848 x 848 pixels; nonmydriatic; camera: NIDEK AFC-230; color fundus image.
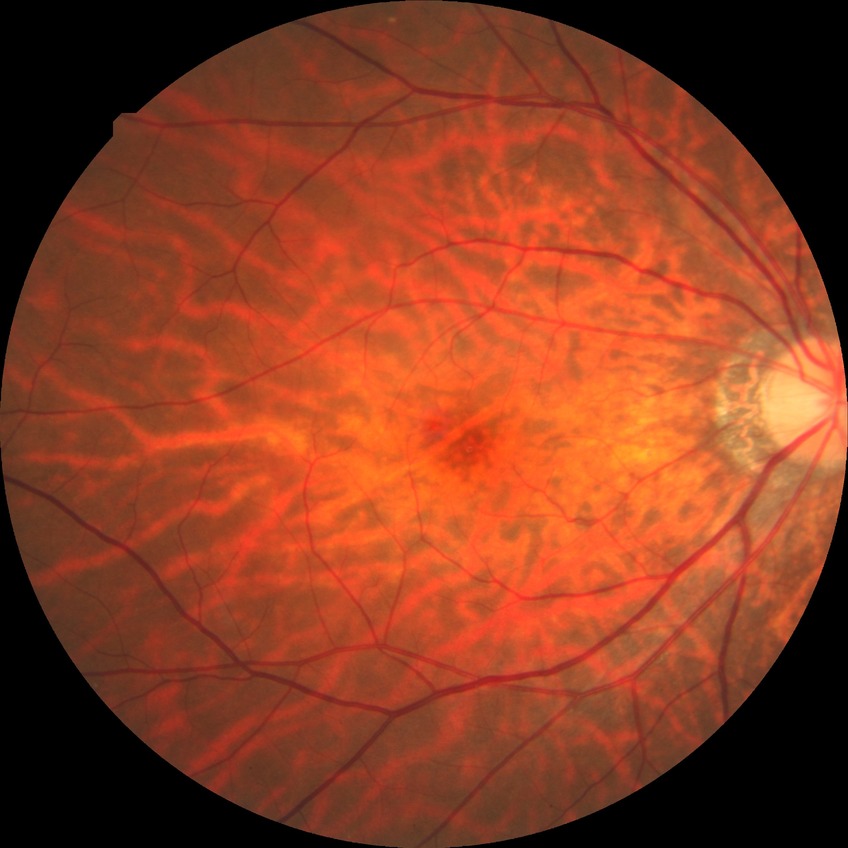 Diabetic retinopathy (DR): NDR (no diabetic retinopathy).